Captured after pupil dilation. Camera: Kowa VX-10α. Macula-centered. Color fundus image — 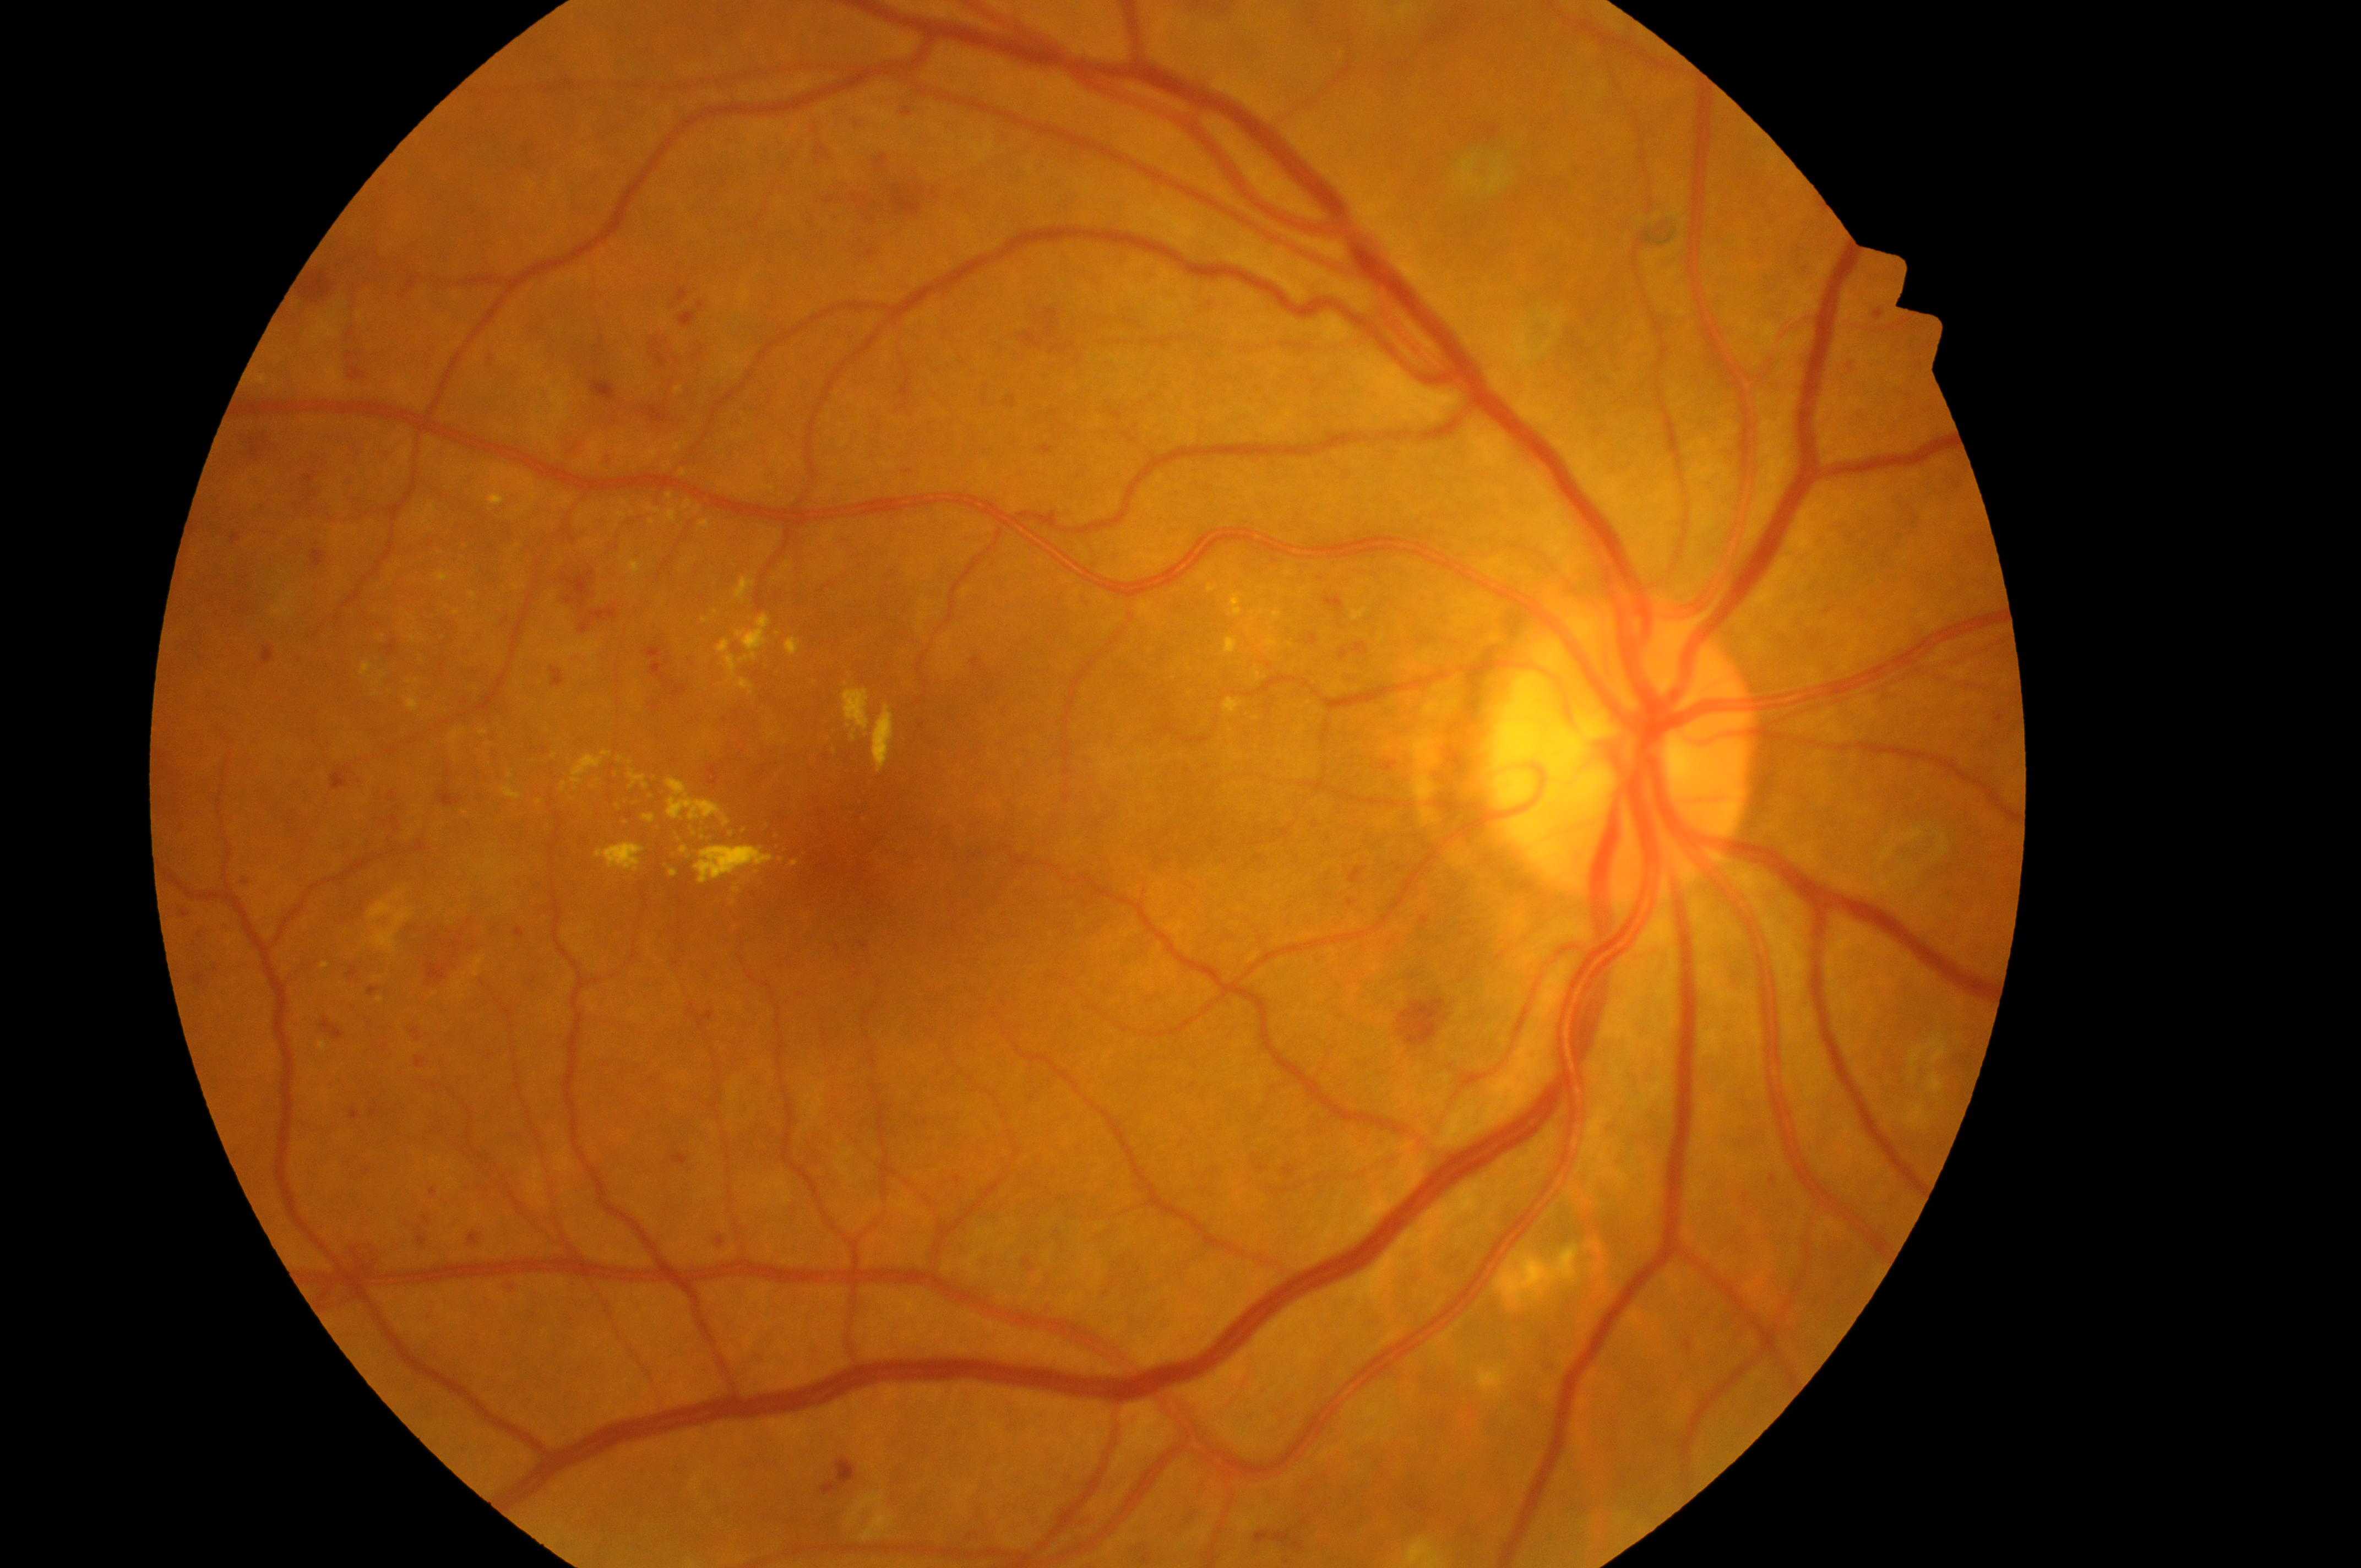 Risk of macular edema: grade 2 (high risk). Imaged eye: right eye. Diabetic retinopathy severity is PDR (grade 4). The fovea center is at (844,851). Optic disc: (1619,767).